Optic disc at the center of the field. Fundus photo. 2212x1661. Camera: Topcon TRC-NW400. Patient age: 69 years. Refraction: +1.5 -0.5 x 5. Non-mydriatic. 30-degree field of view. Intraocular pressure (IOP) by pneumatic tonometry: 19 mmHg:
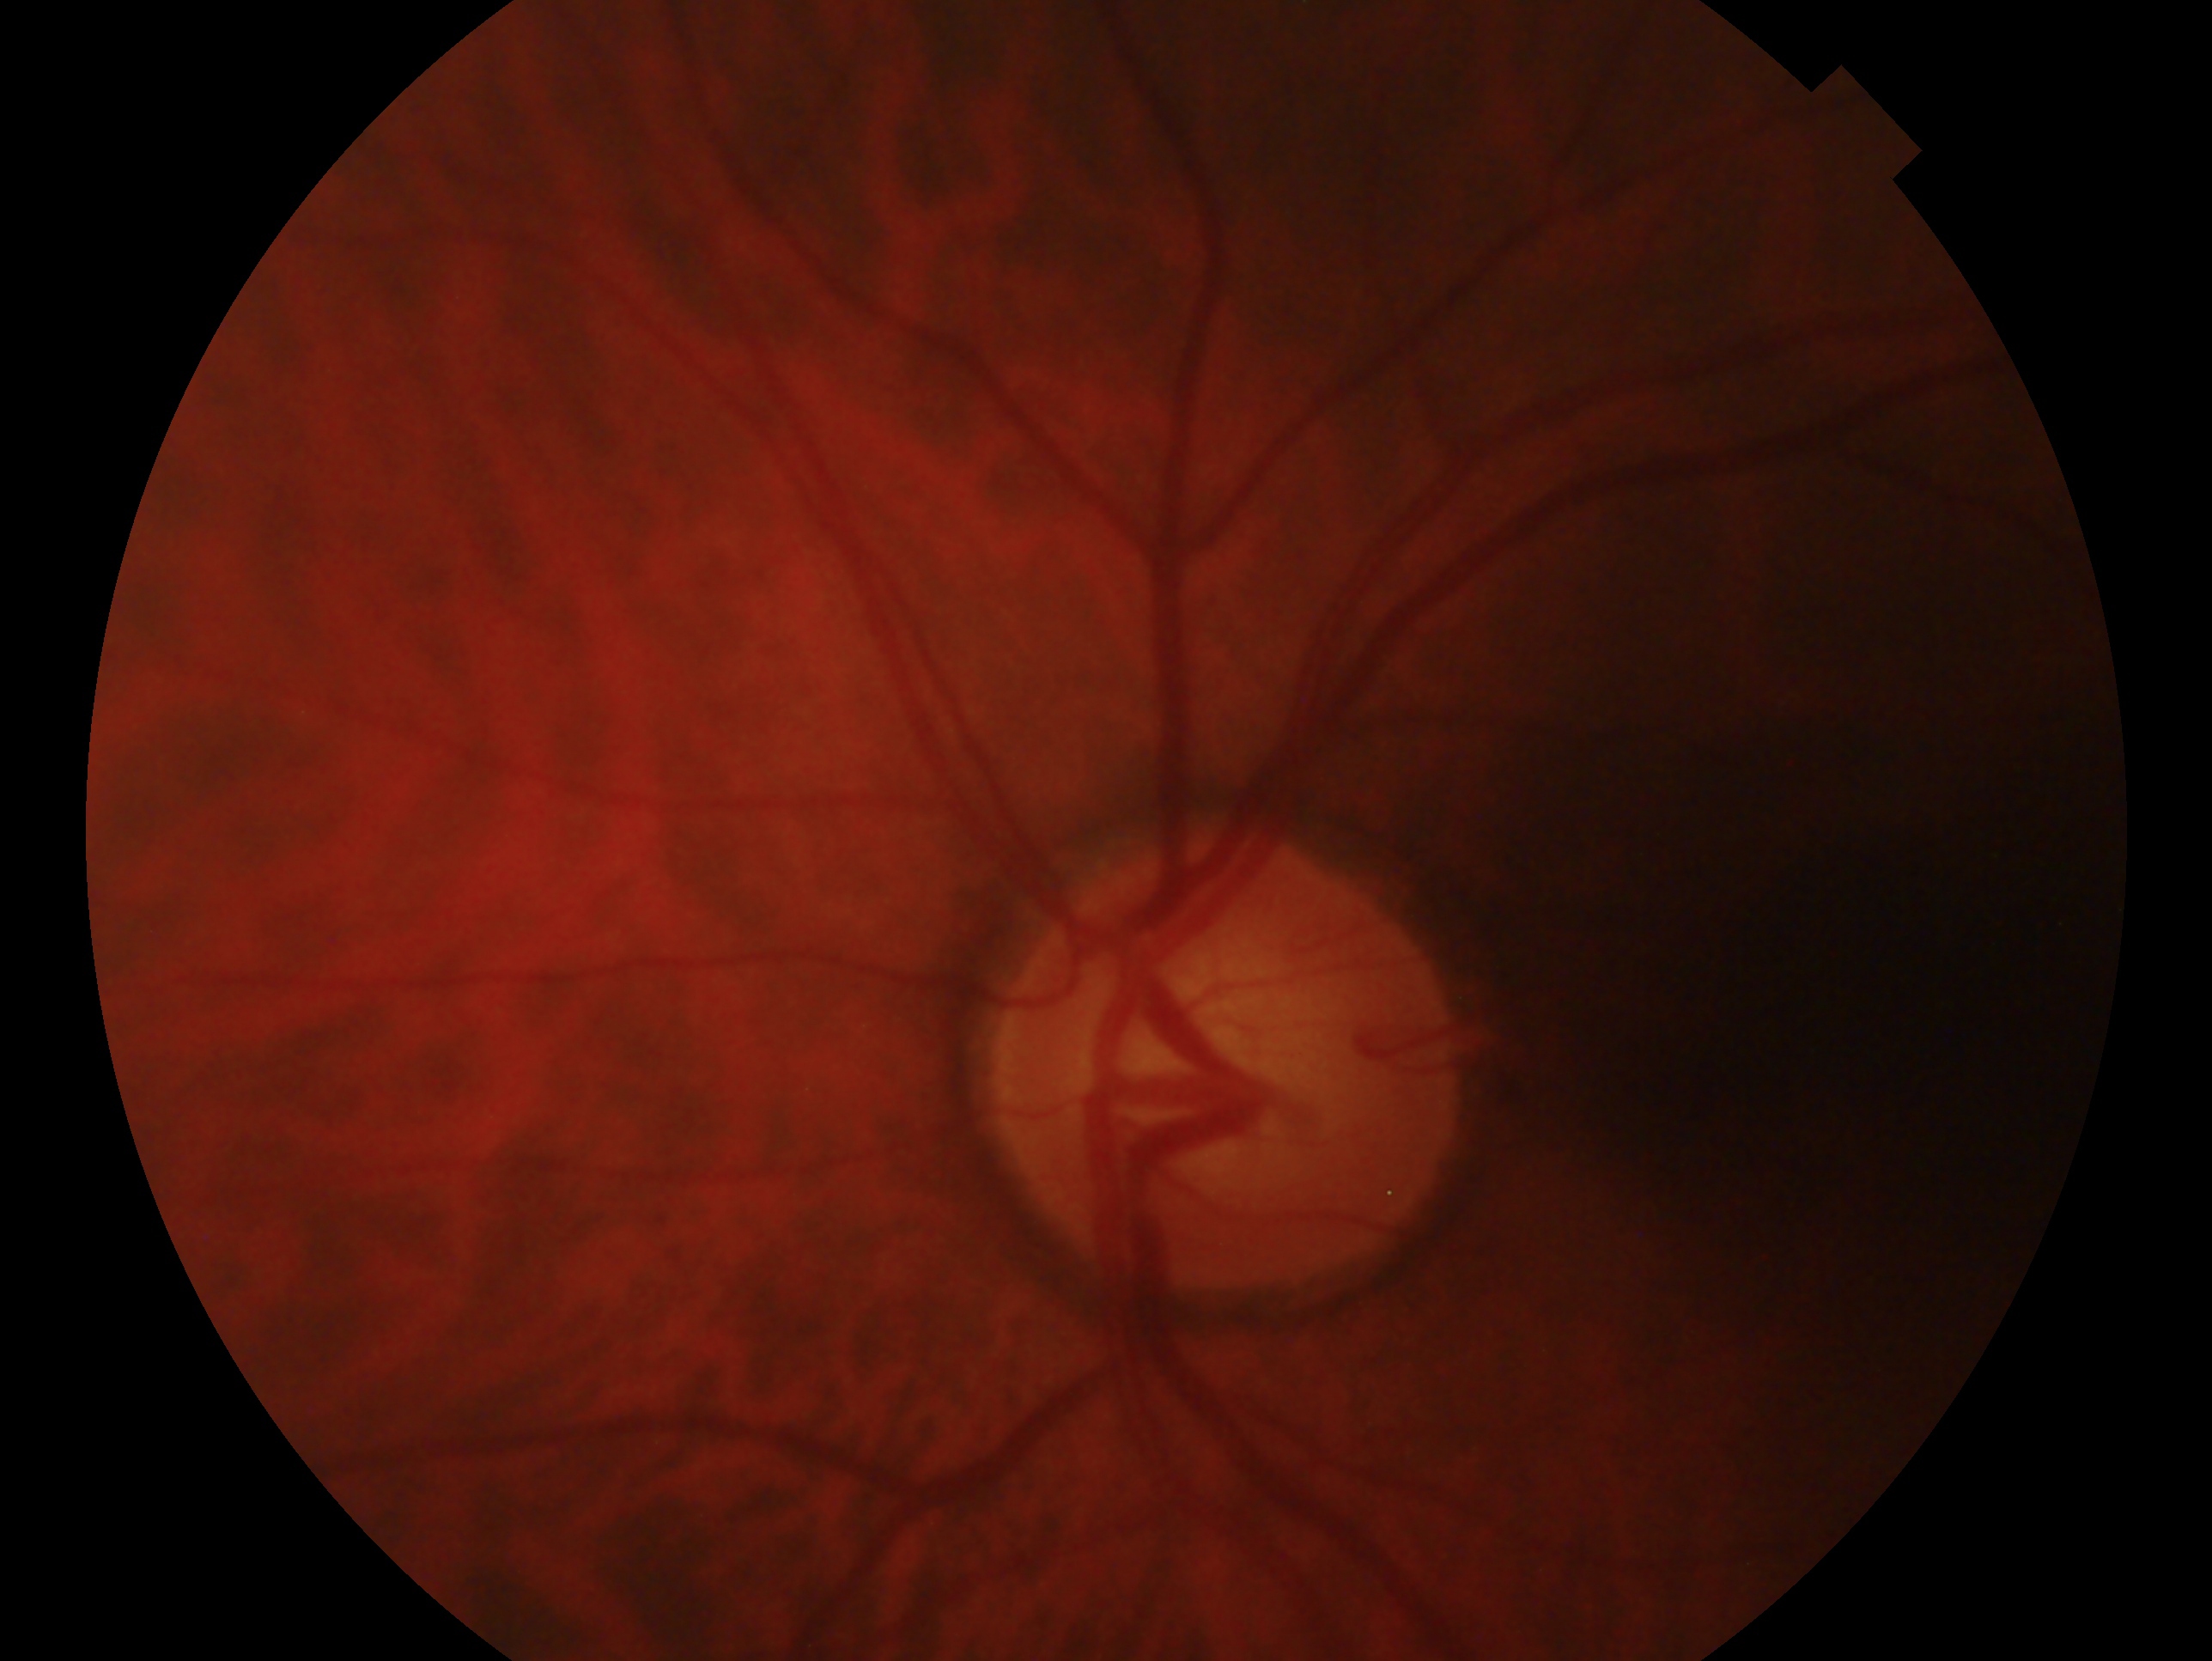

Annotations:
– laterality · oculus sinister
– glaucoma status · consistent with glaucoma